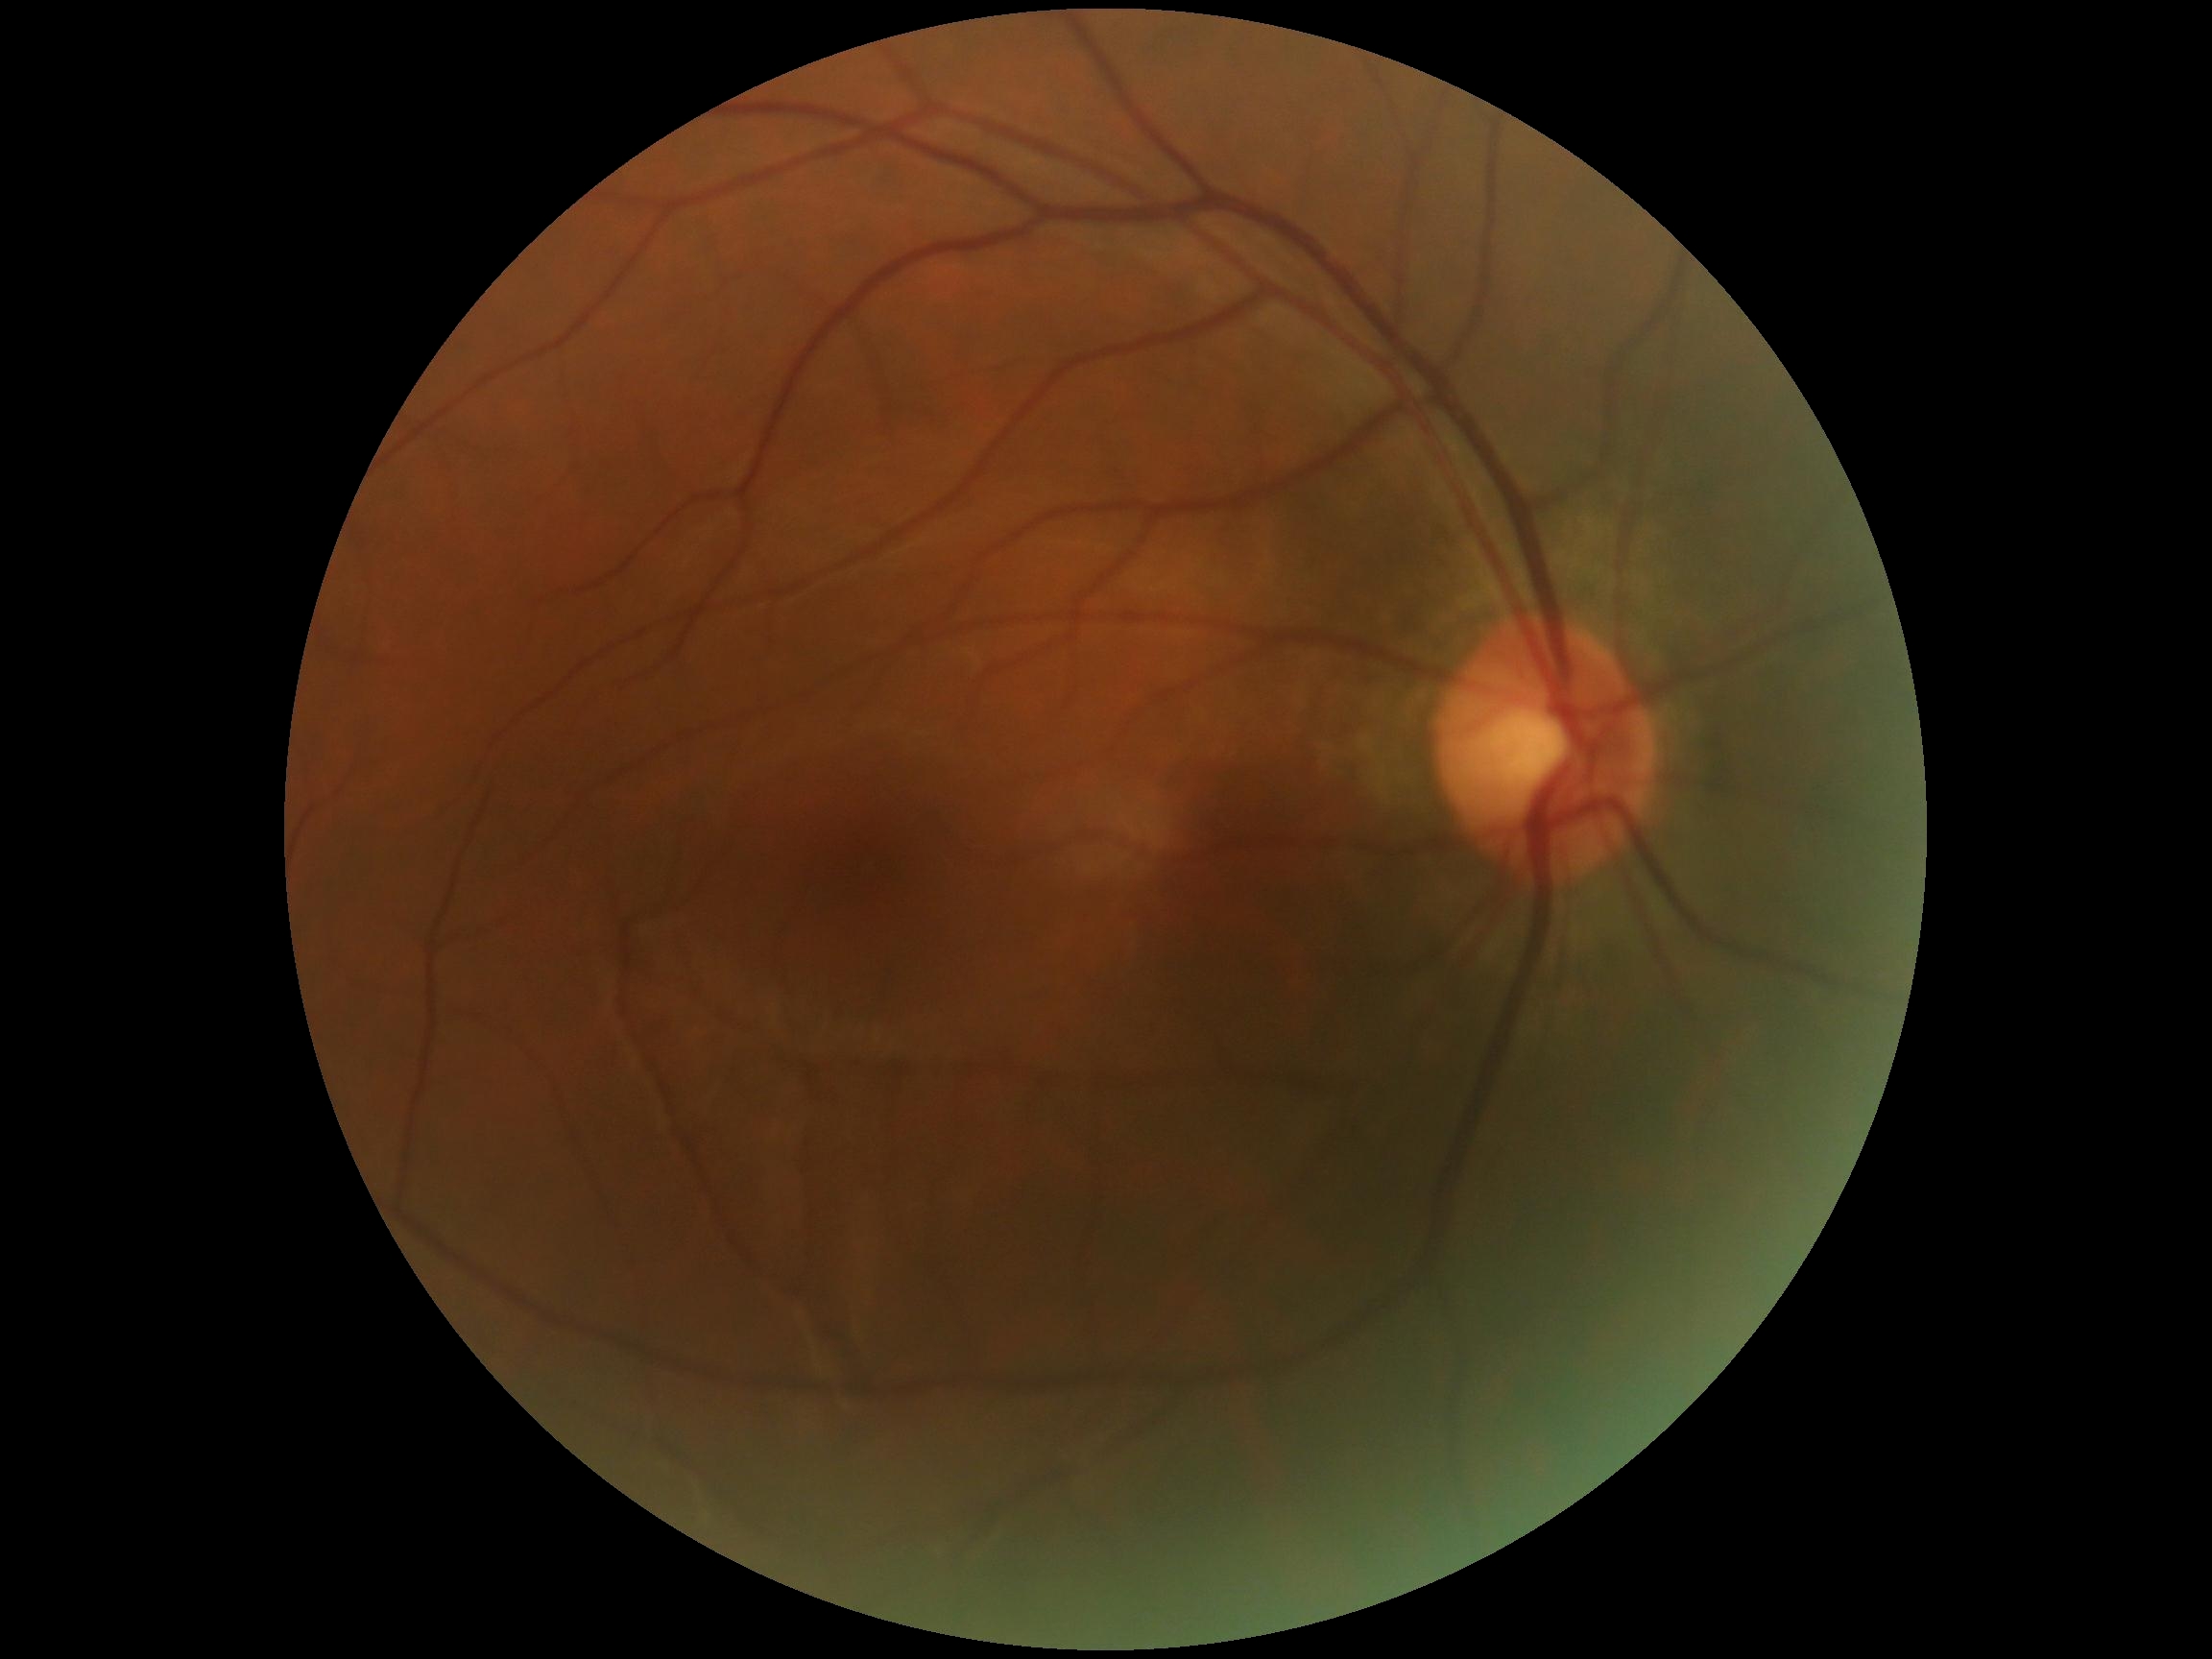
Annotations:
* DR impression — negative for DR
* DR stage — grade 0 (no apparent retinopathy)